Camera: Kowa VX-10α; 2361 x 1568 pixels; CFP.
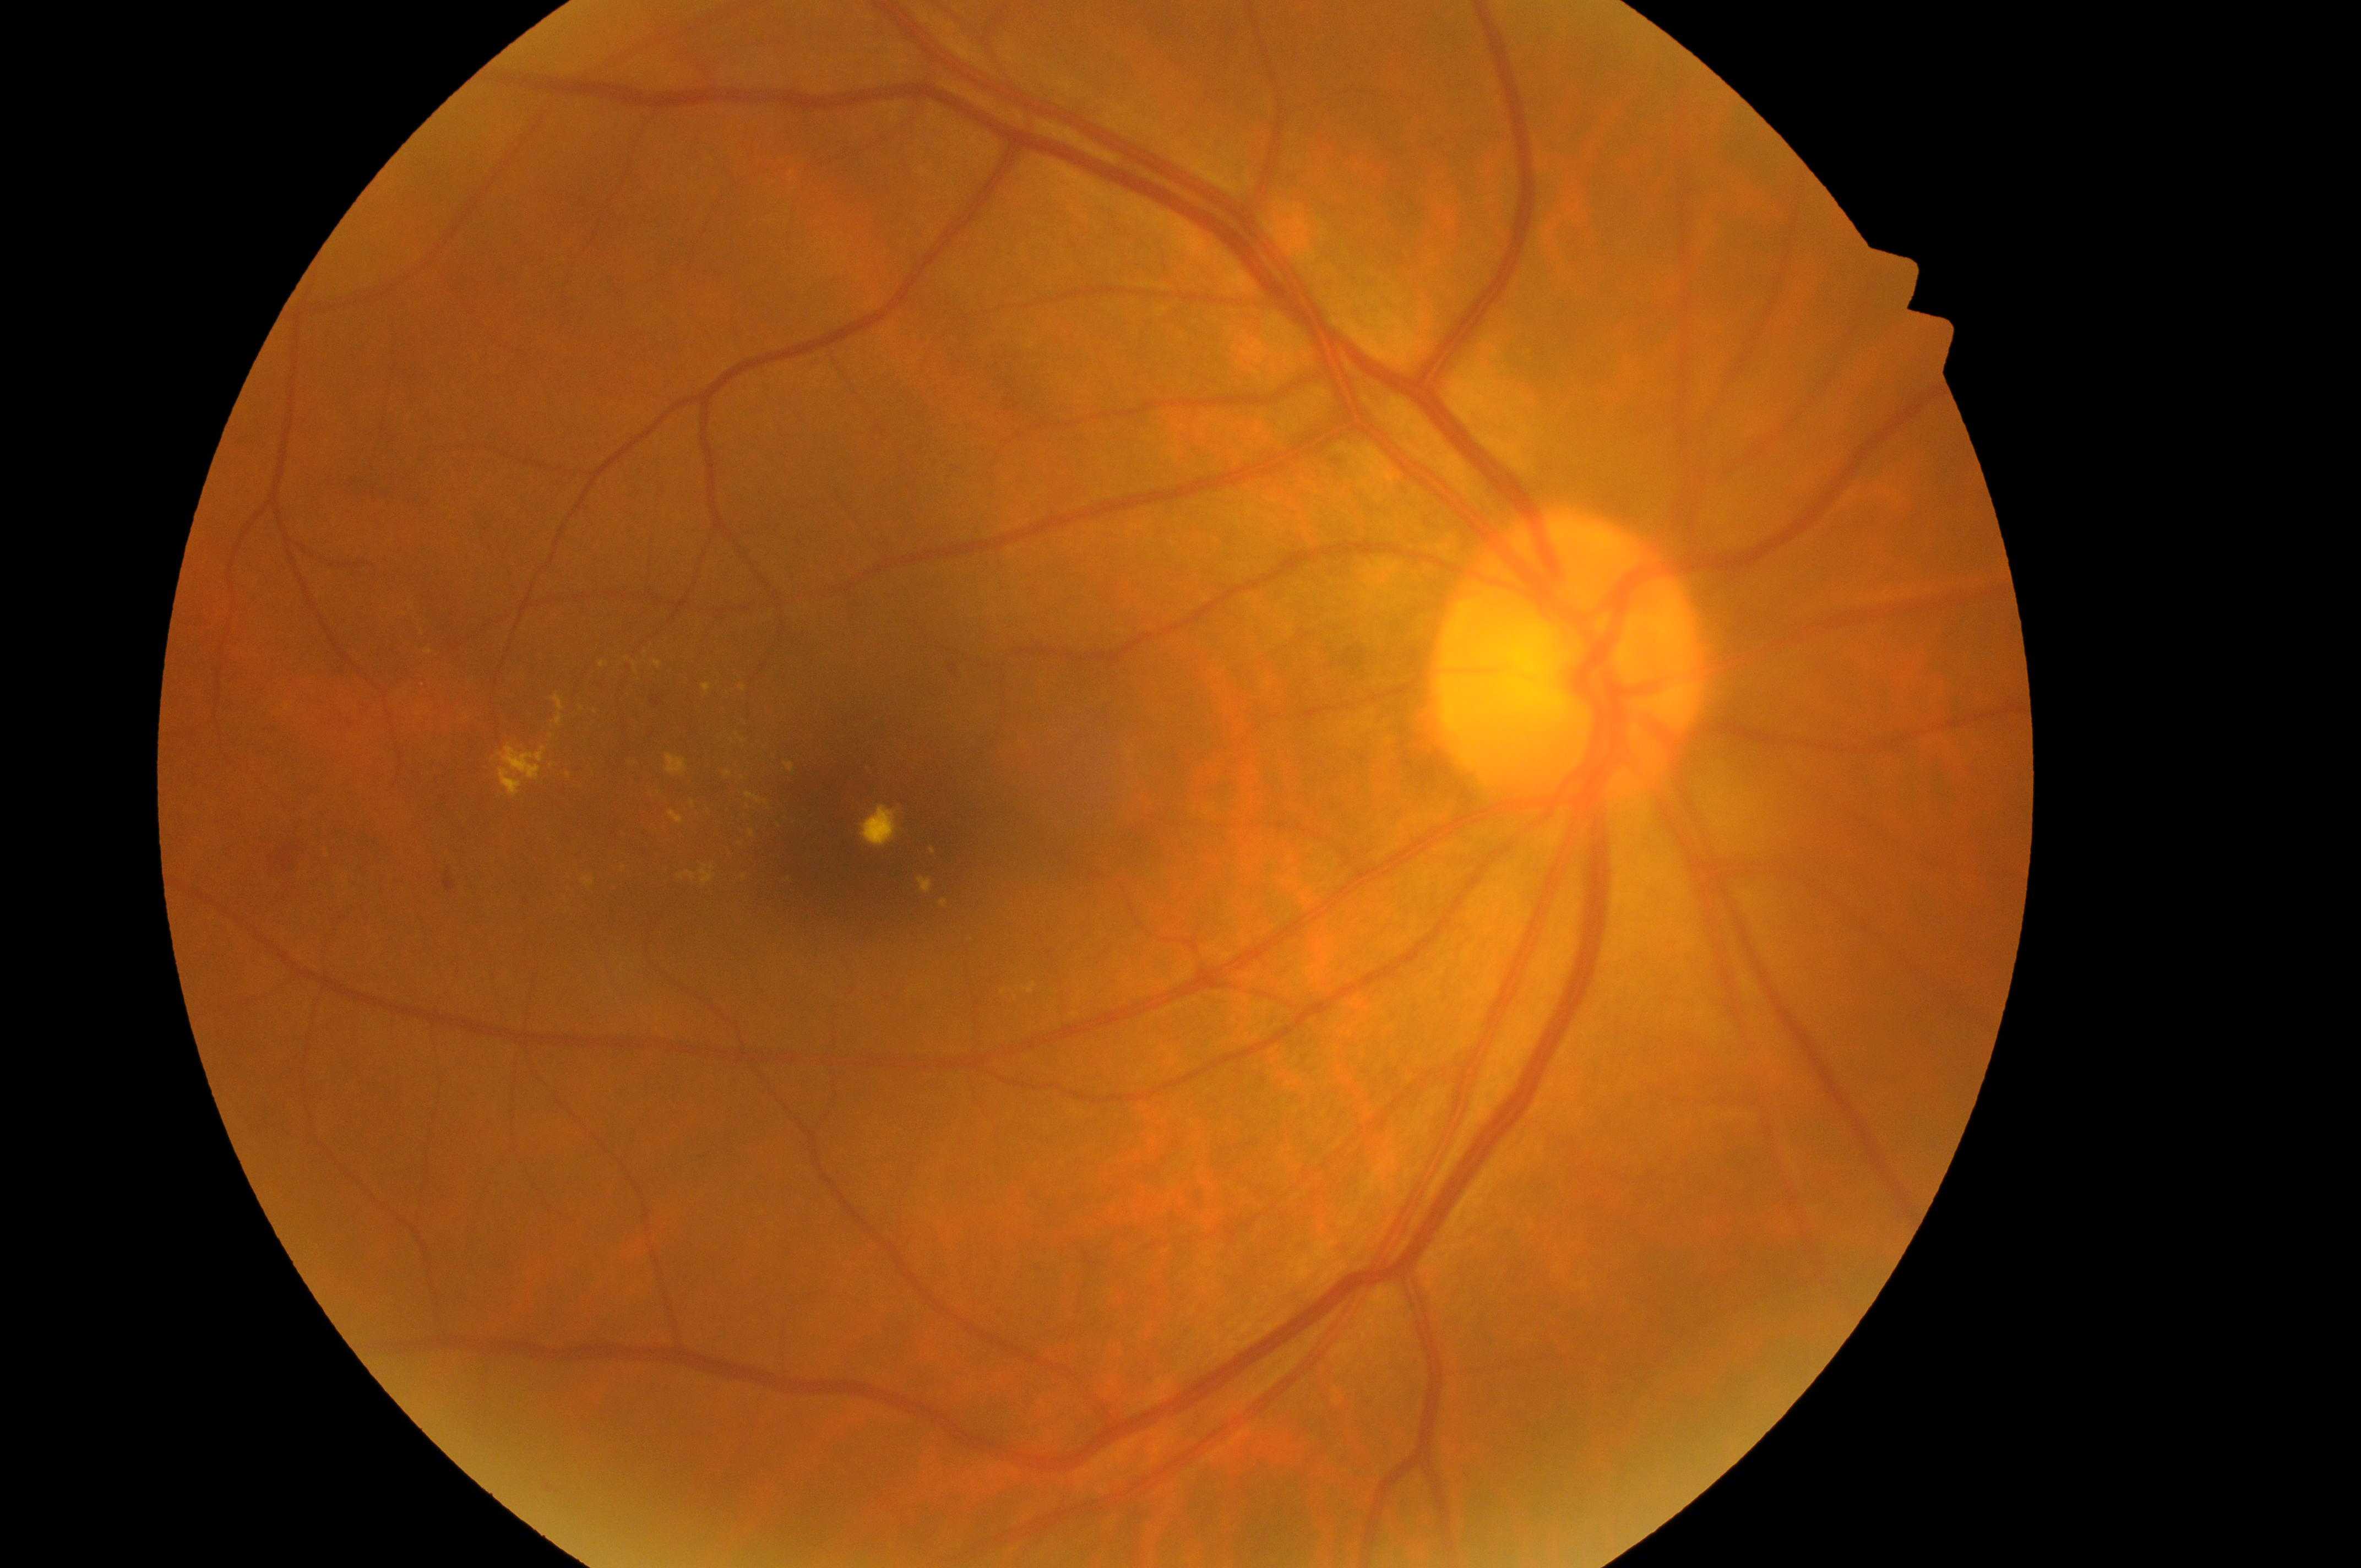
ONH = x=1565, y=682
fovea center = x=858, y=845
DME risk = grade 2 (high risk) — hard exudates within one disc diameter of the macula center
DR stage = grade 2 (moderate NPDR) — more than just microaneurysms but less than severe NPDR
laterality = right eye